Color fundus image. FOV: 45 degrees: 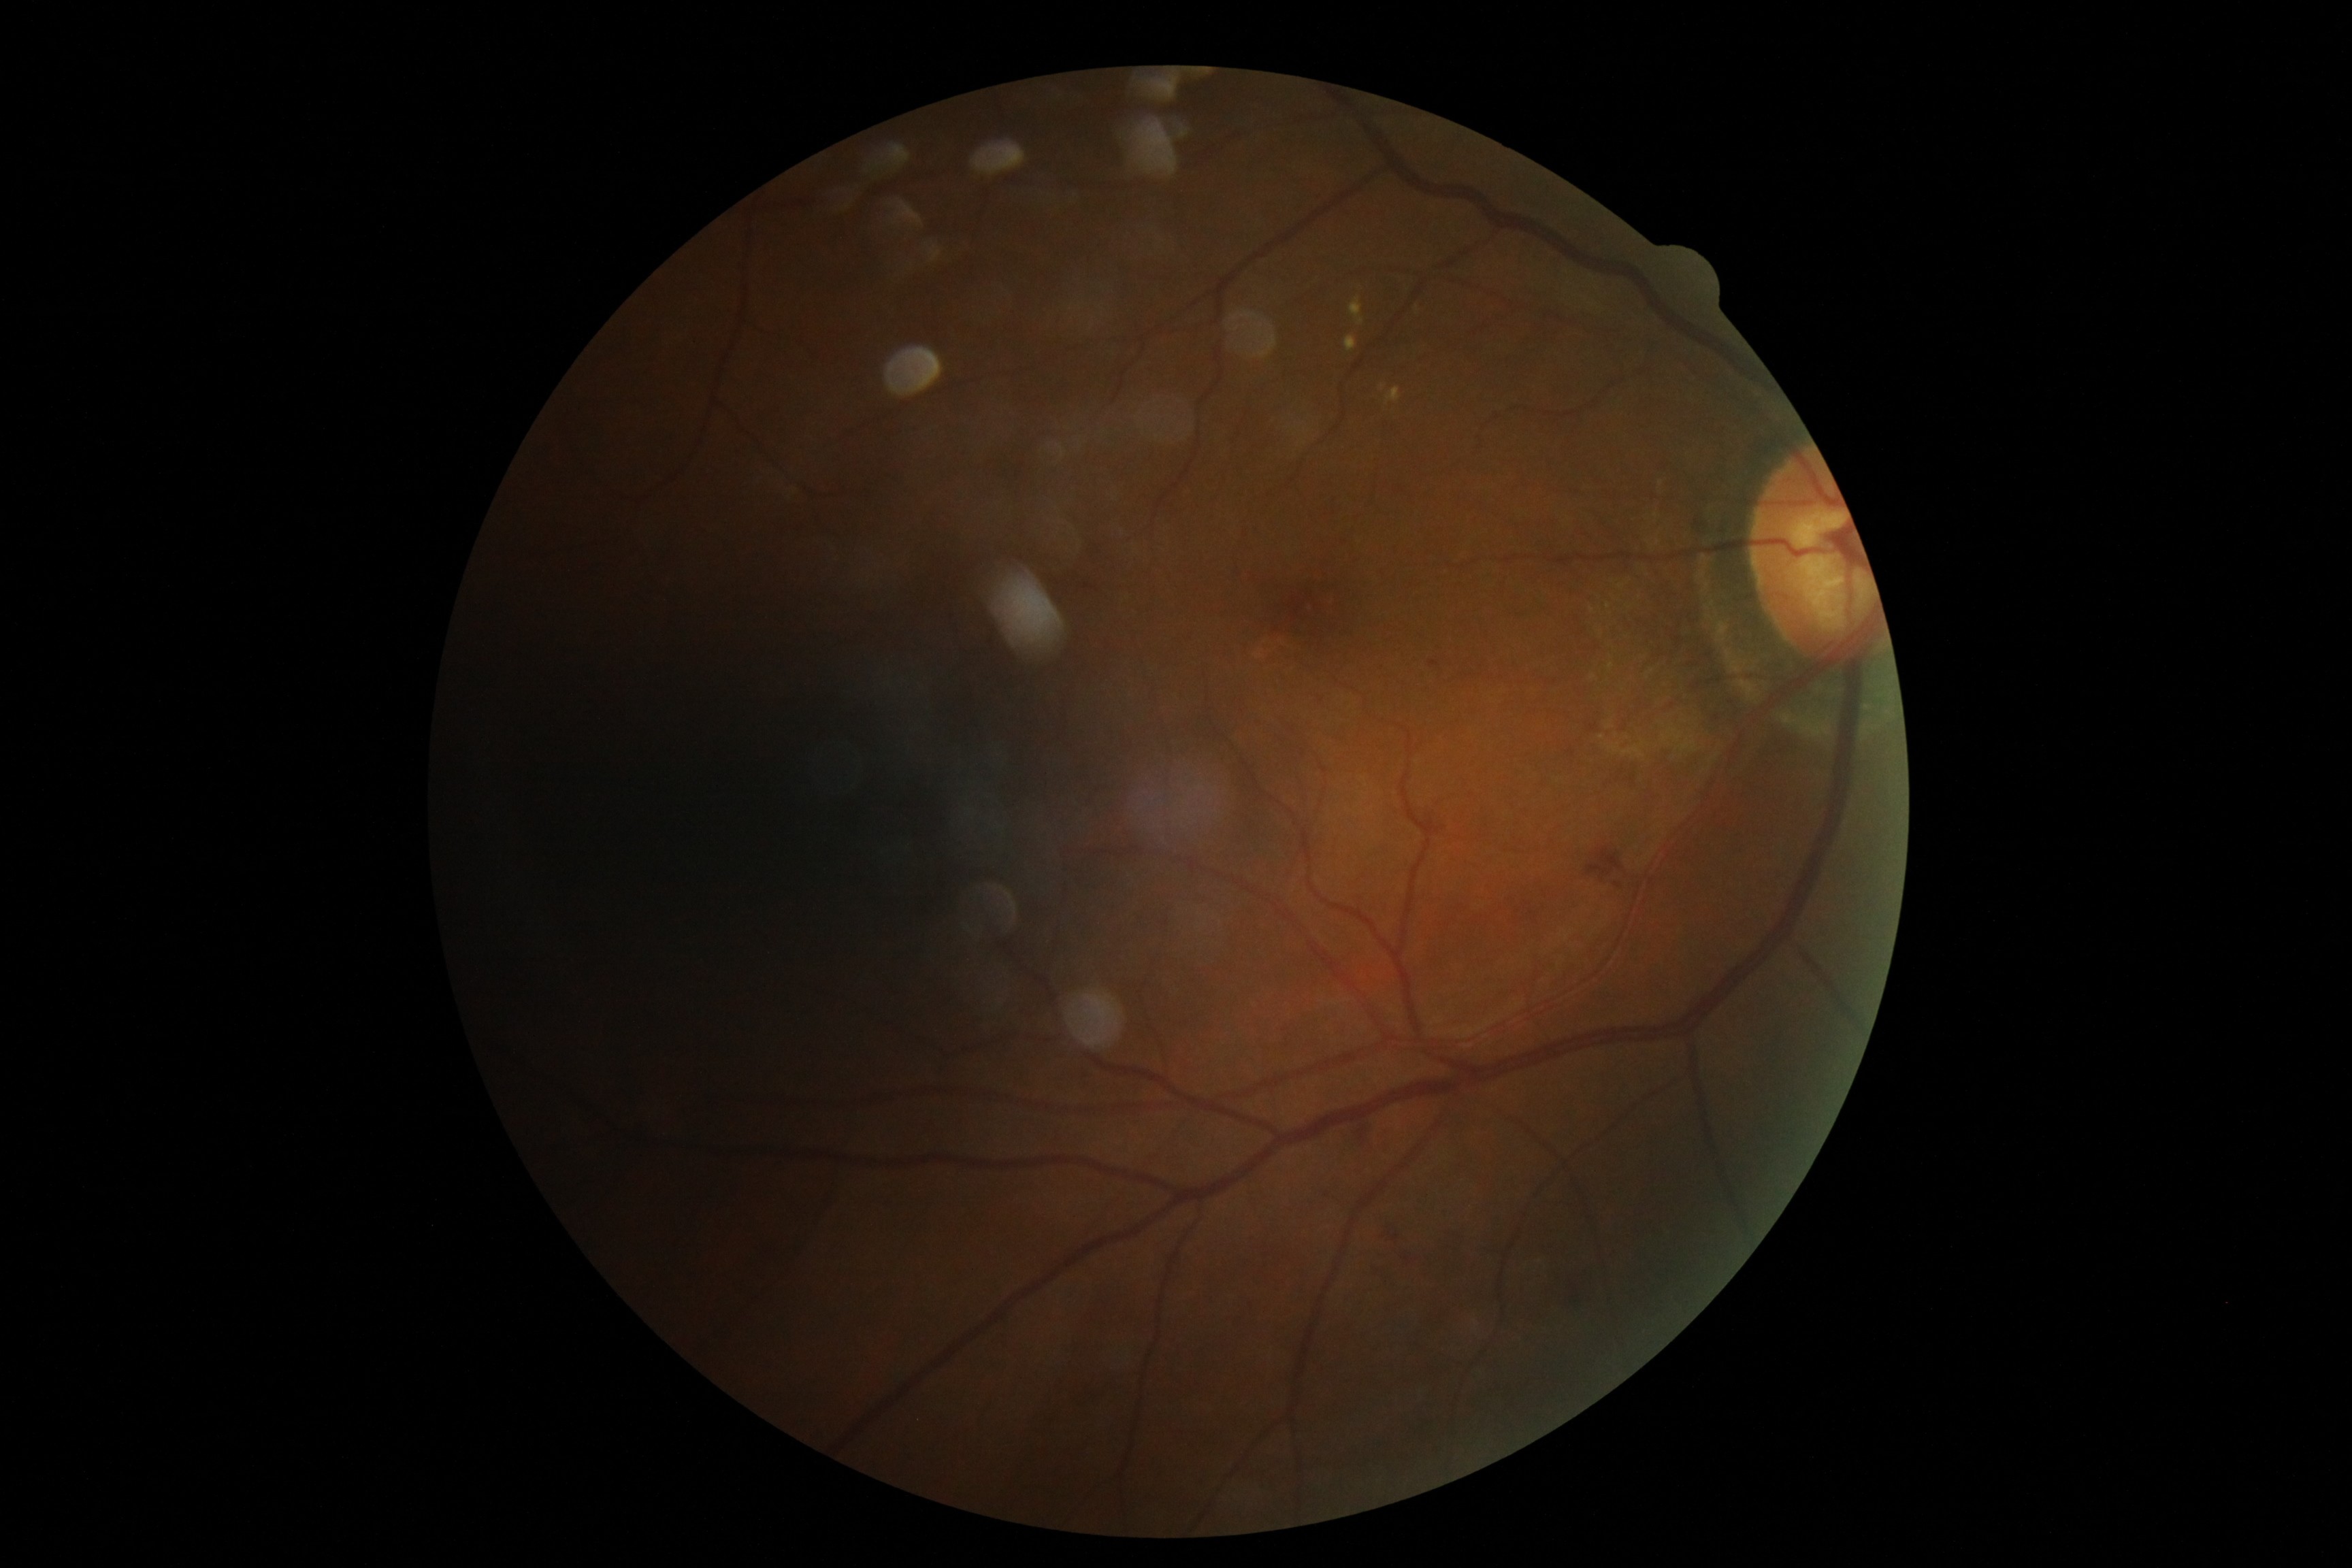
DR severity is grade 2 — more than just microaneurysms but less than severe NPDR.